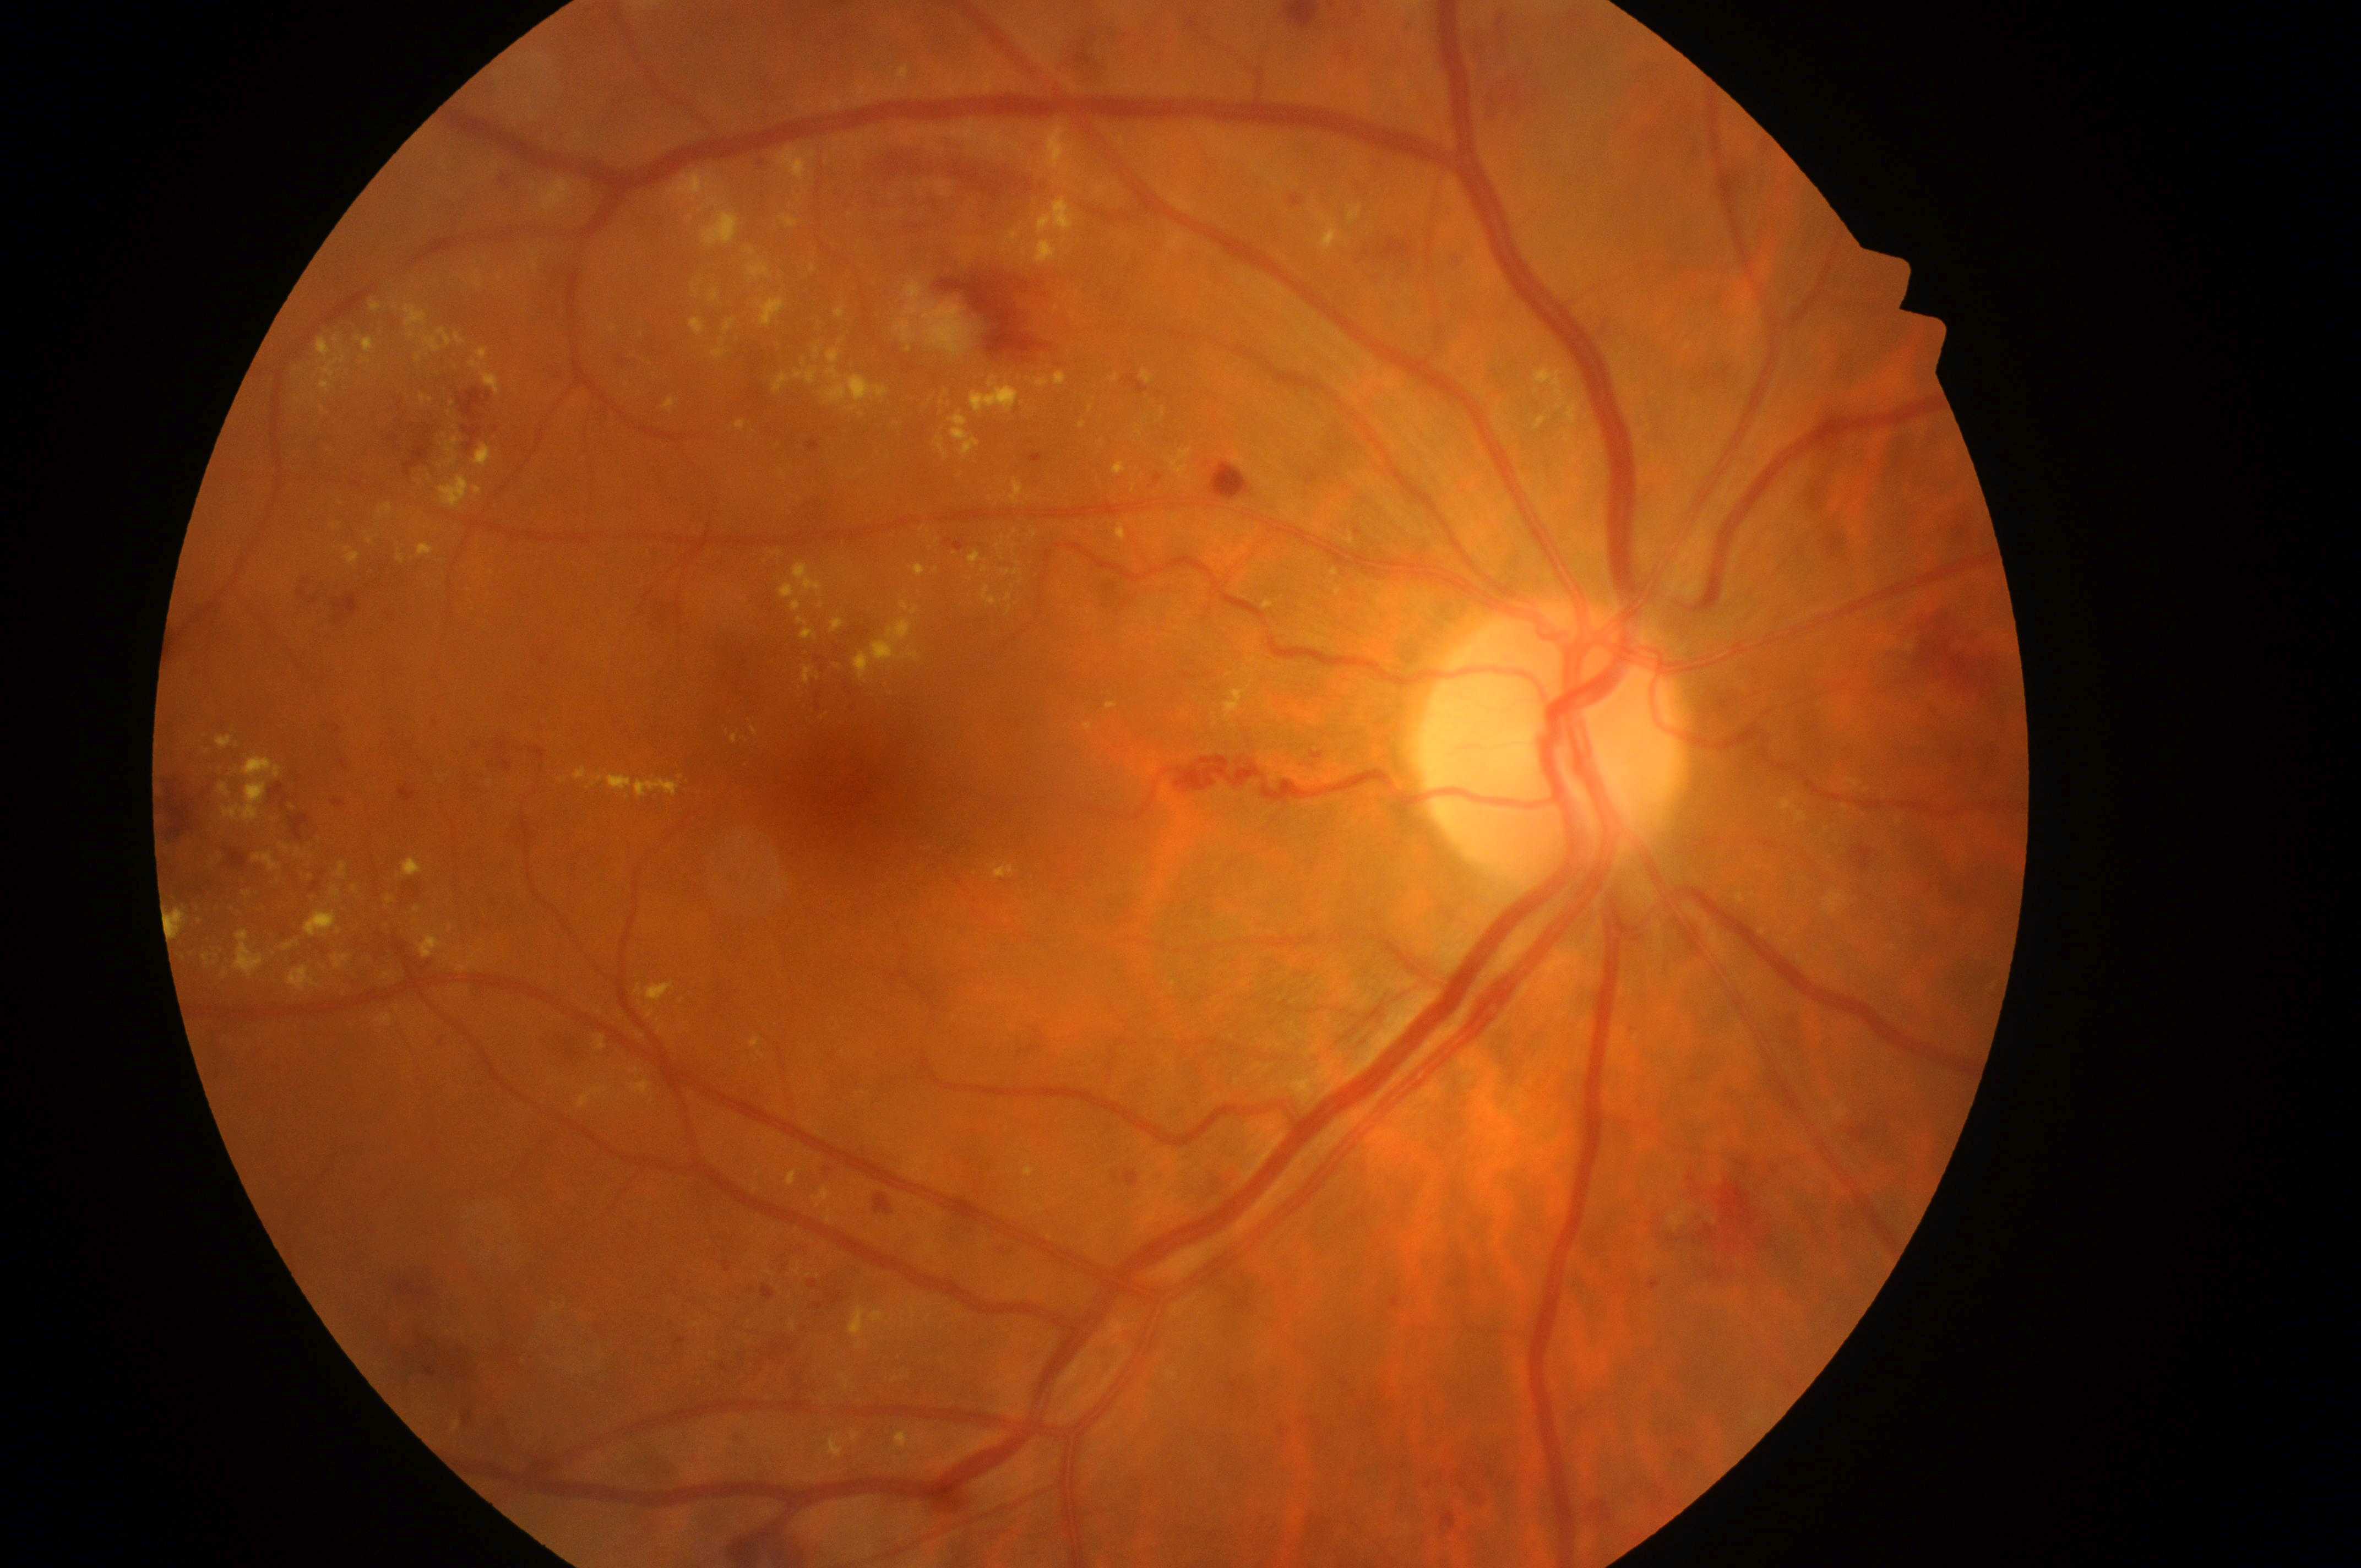
DR class: non-proliferative diabetic retinopathy.
Macular edema risk: 2.
The macula center is at [856, 790].
The optic disc is at [1551, 750].
Eye: OD.
Diabetic retinopathy: 3/4.